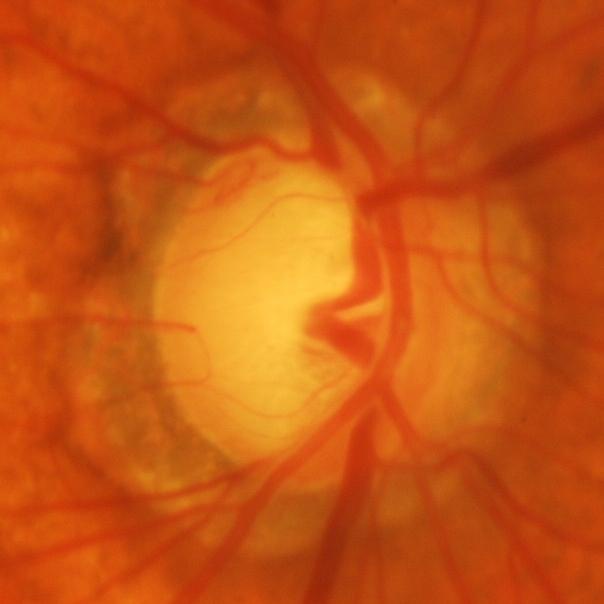

Glaucoma is present. Optic disc appearance consistent with glaucomatous optic neuropathy.